45-degree field of view; image size 1932x1916: 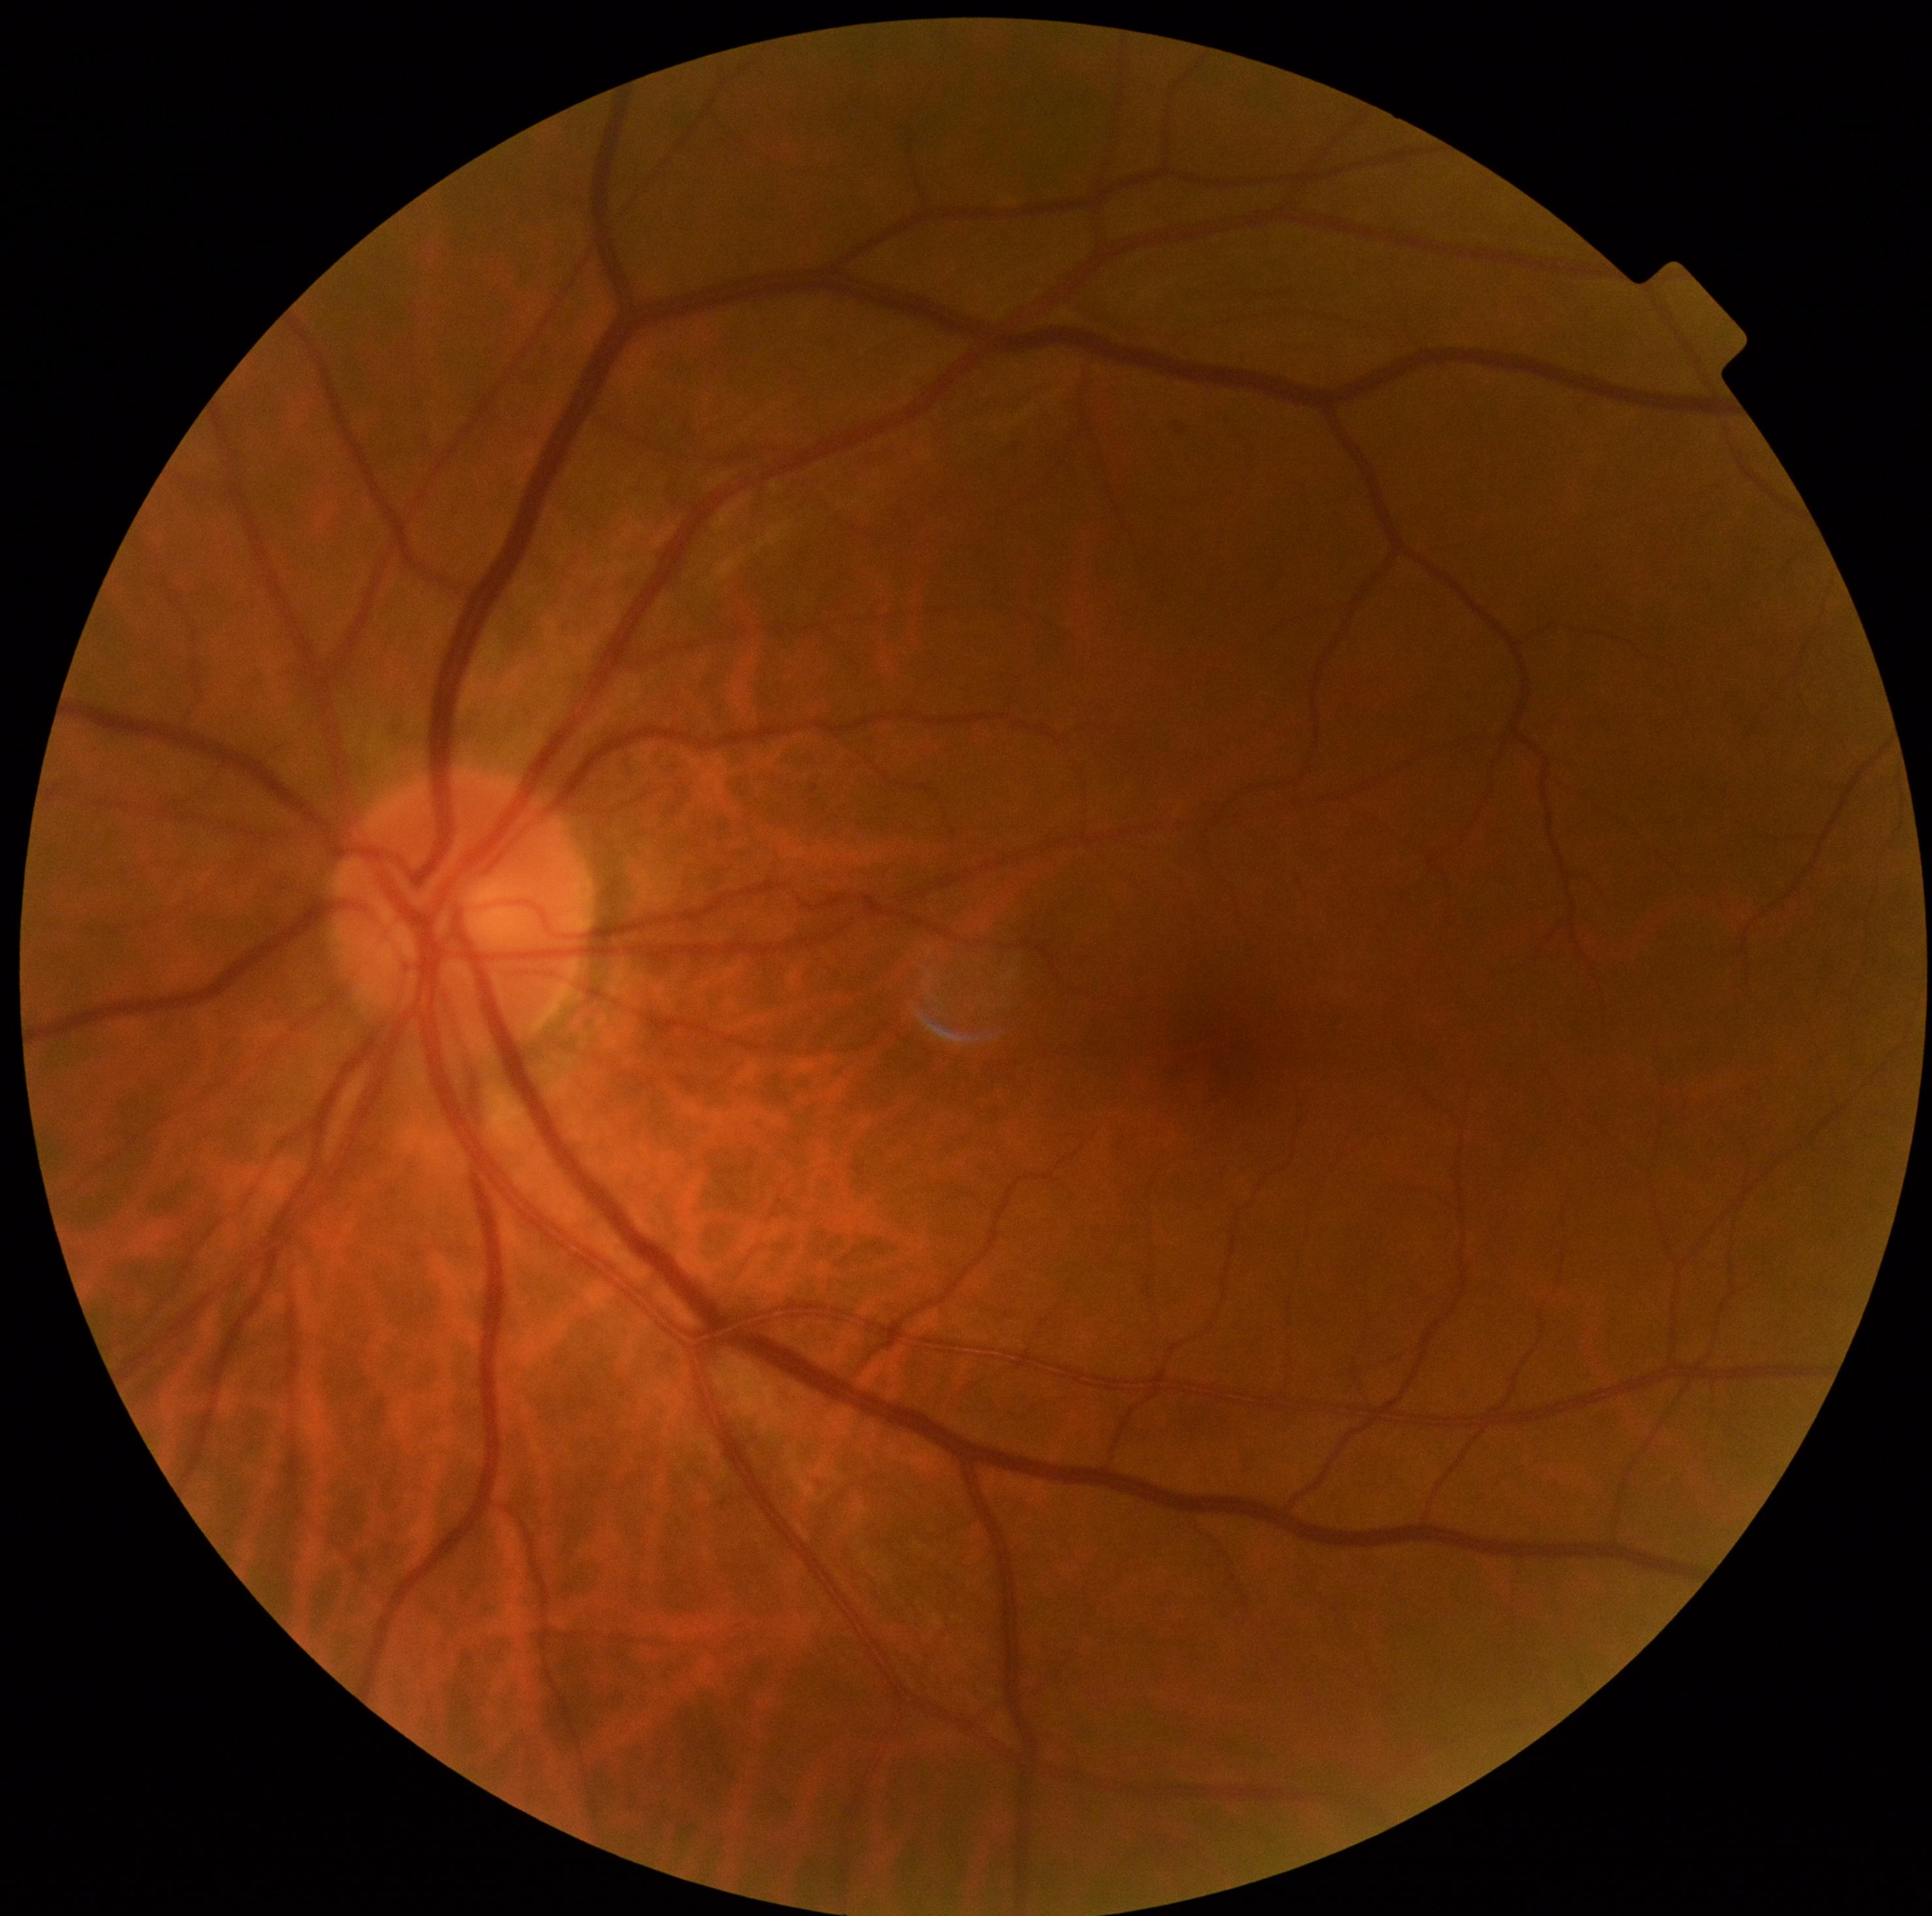
Findings:
– diabetic retinopathy (DR): 0/4